848 x 848 pixels · without pupil dilation · NIDEK AFC-230 · CFP · 45° FOV
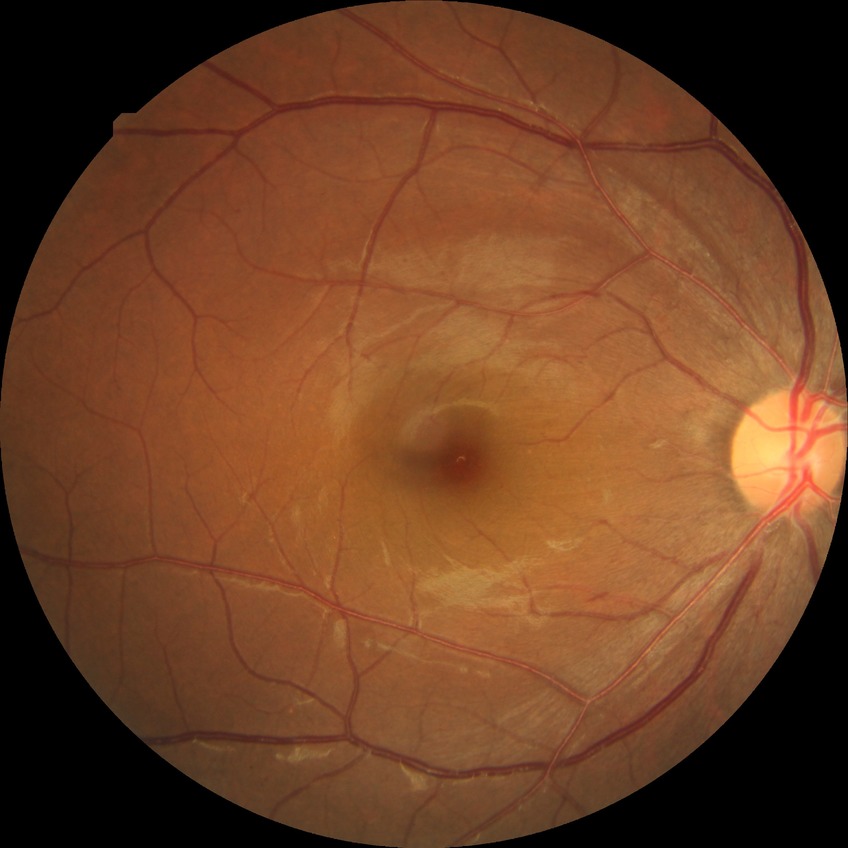 DR class=non-proliferative diabetic retinopathy; DR stage=SDR.